Graded on the modified Davis scale. Retinal fundus photograph.
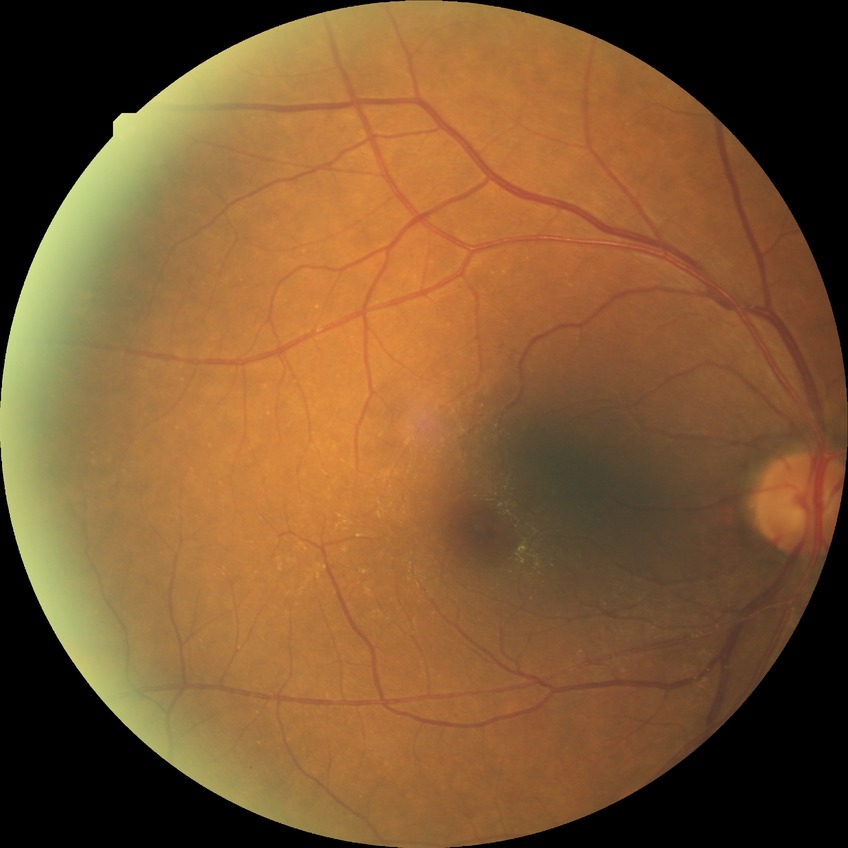

Davis grading=simple diabetic retinopathy.